Acquired with a Topcon TRC-50DX · 50° field of view
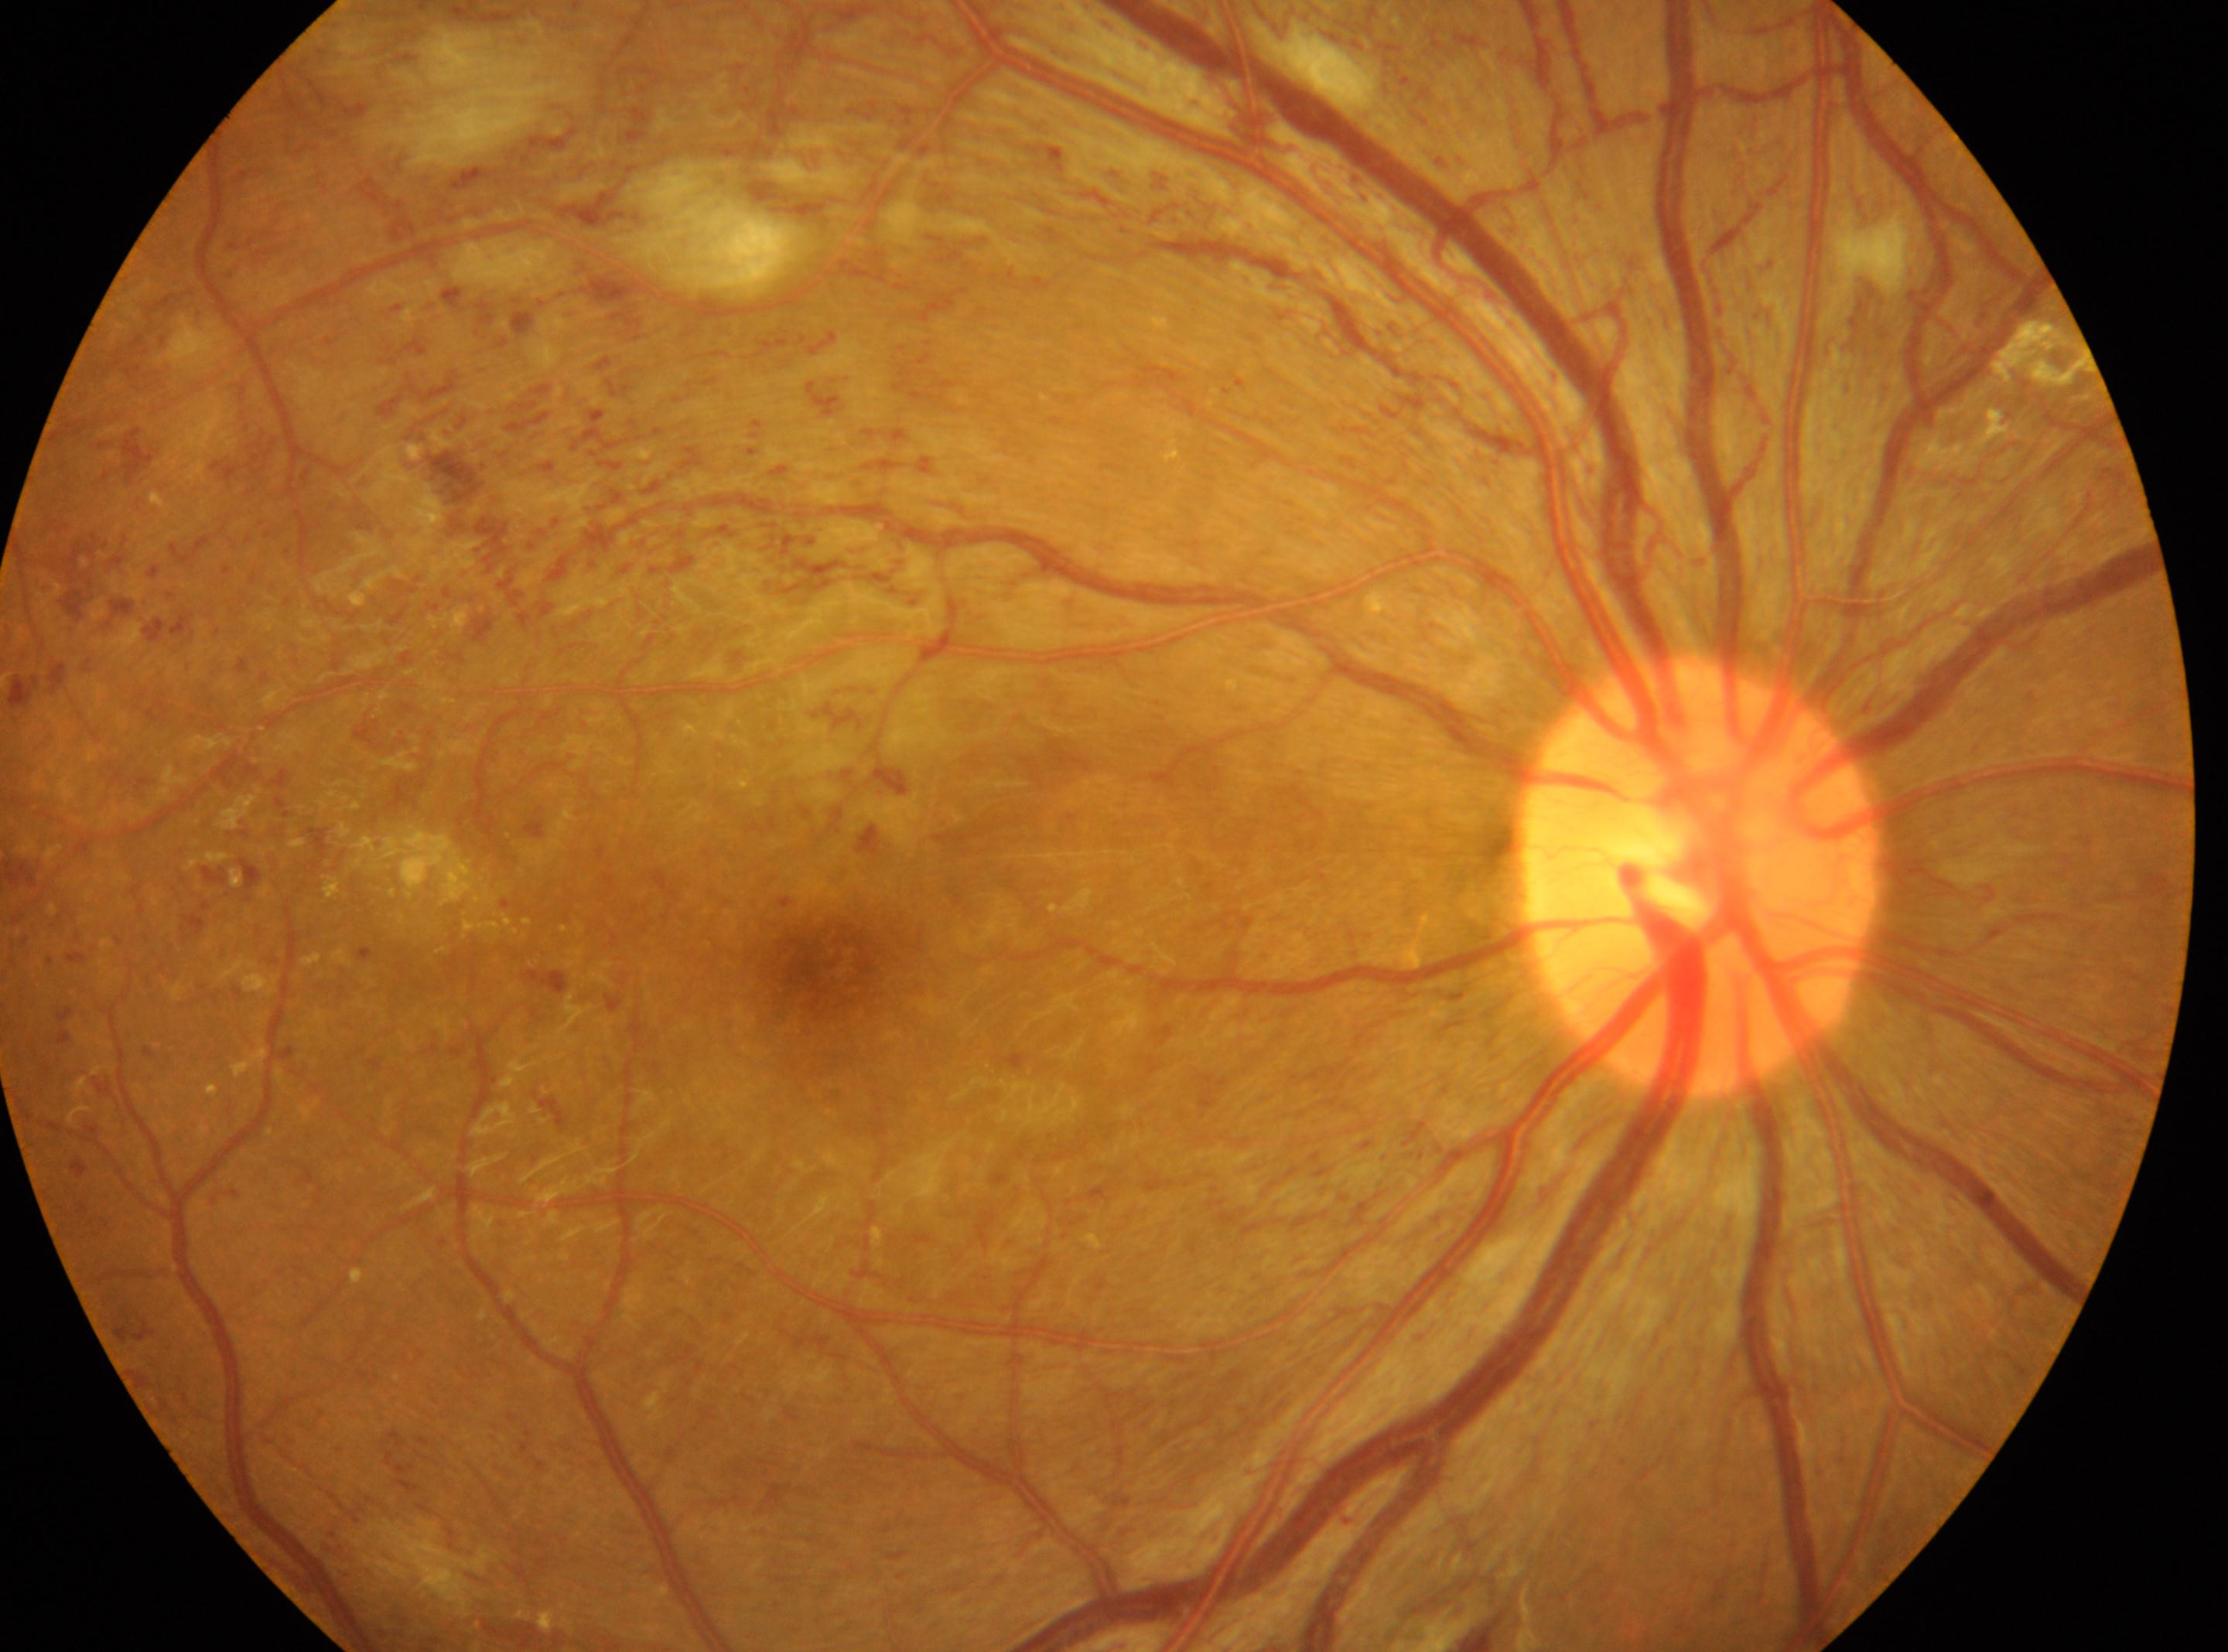

| field | value |
|---|---|
| diabetic retinopathy (DR) | PDR (grade 4) |
| laterality | the right eye |
| ONH | (1700,879) |
| fovea | (820,957) |